45-degree field of view. Retinal fundus photograph. 2212x1659.
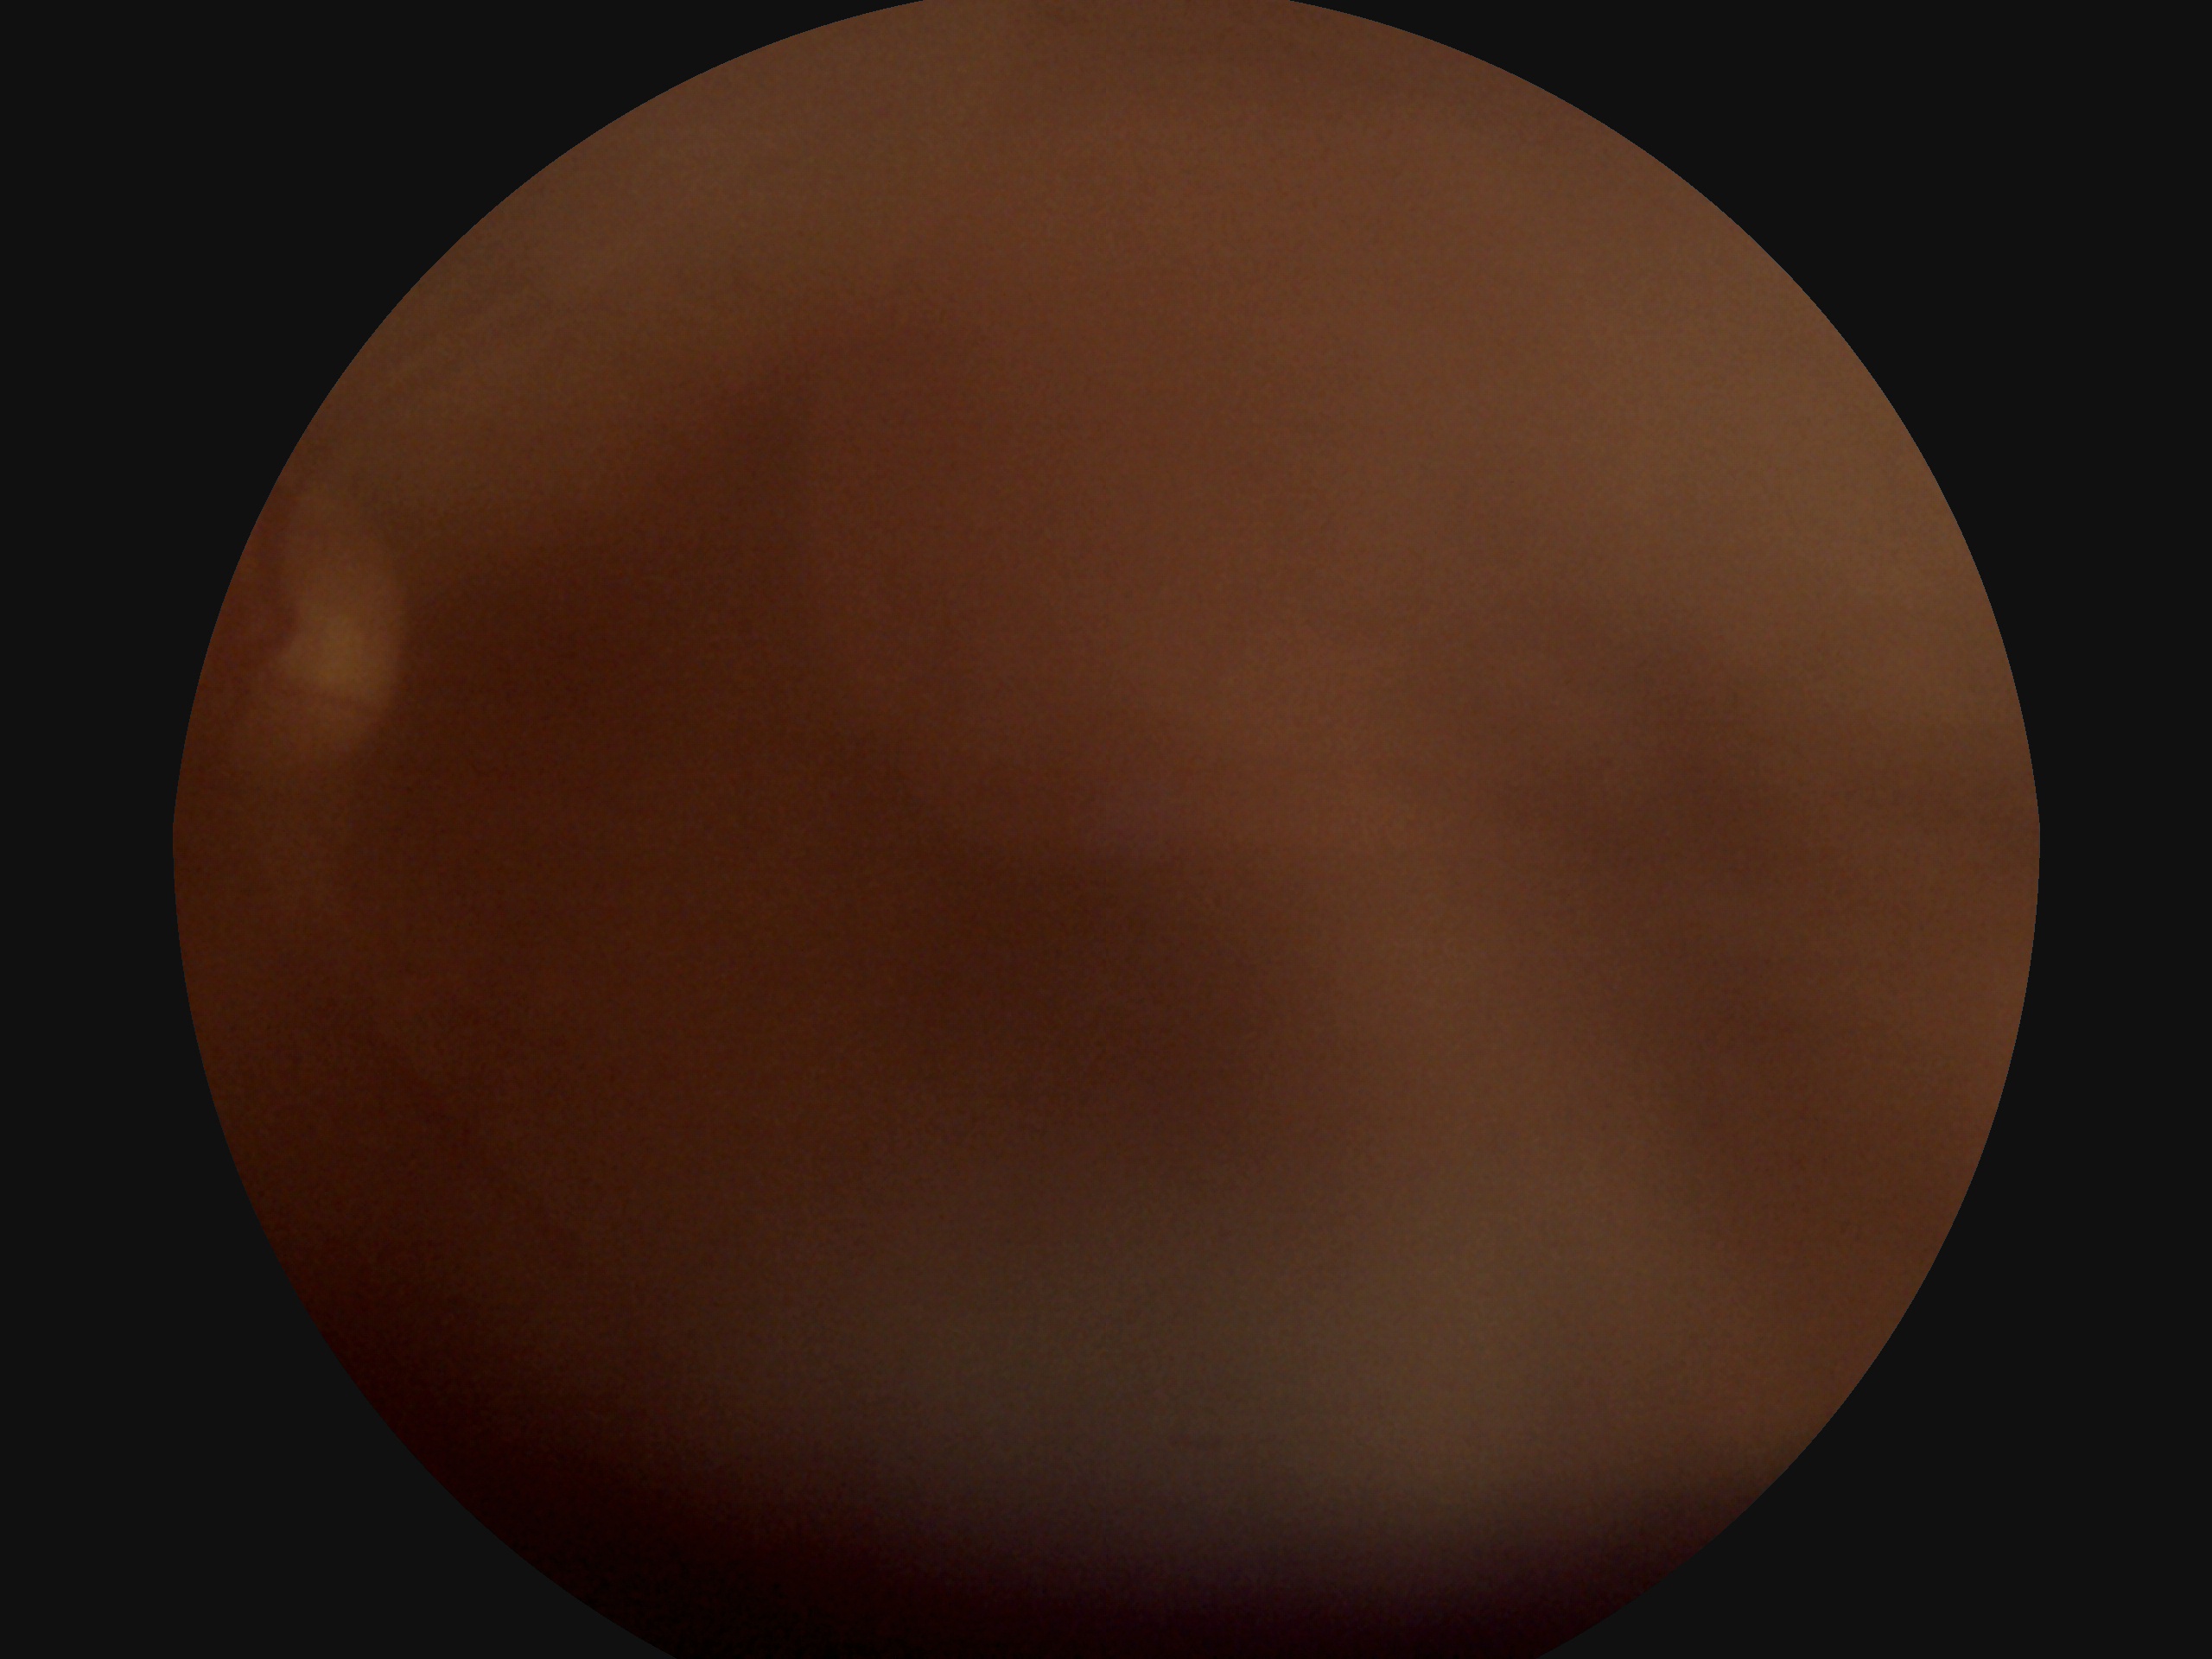 diabetic retinopathy (DR): ungradable.